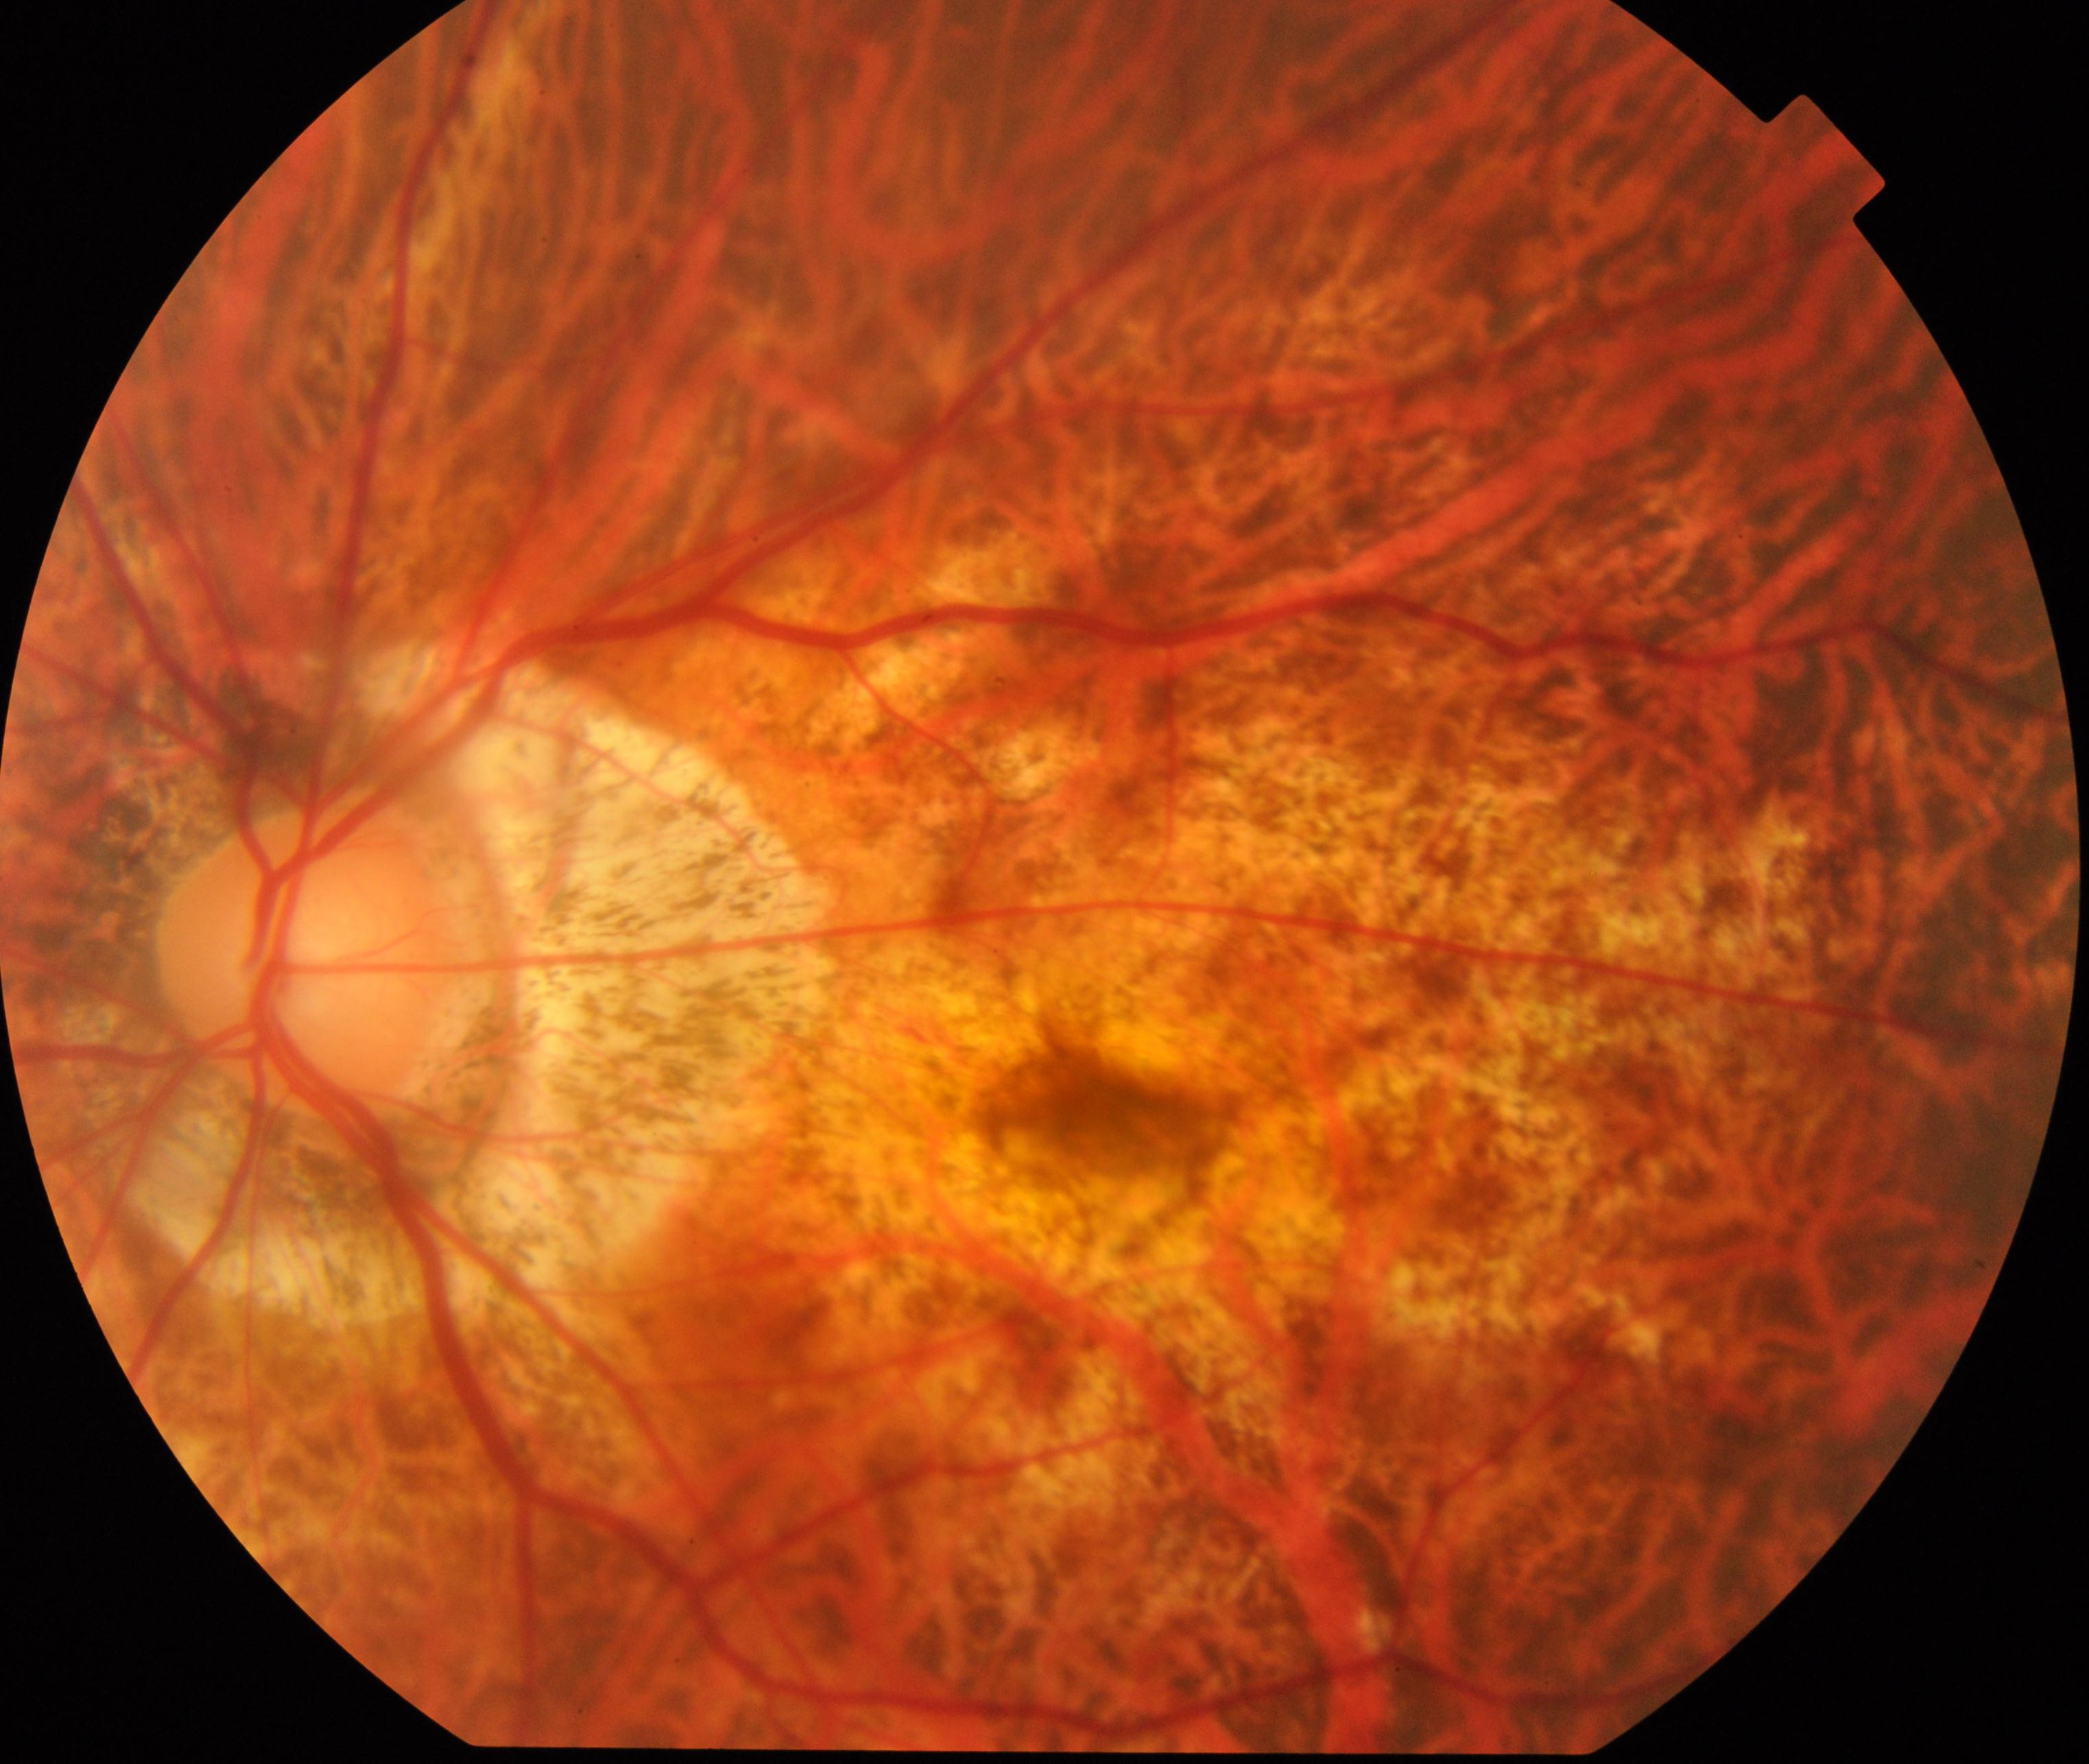
Impression: pathological myopia. Typically showing tessellated fundus with focal chorioretinal atrophy, Fuchs spot, lacquer cracks, choroidal neovascularization, or subretinal hemorrhage.